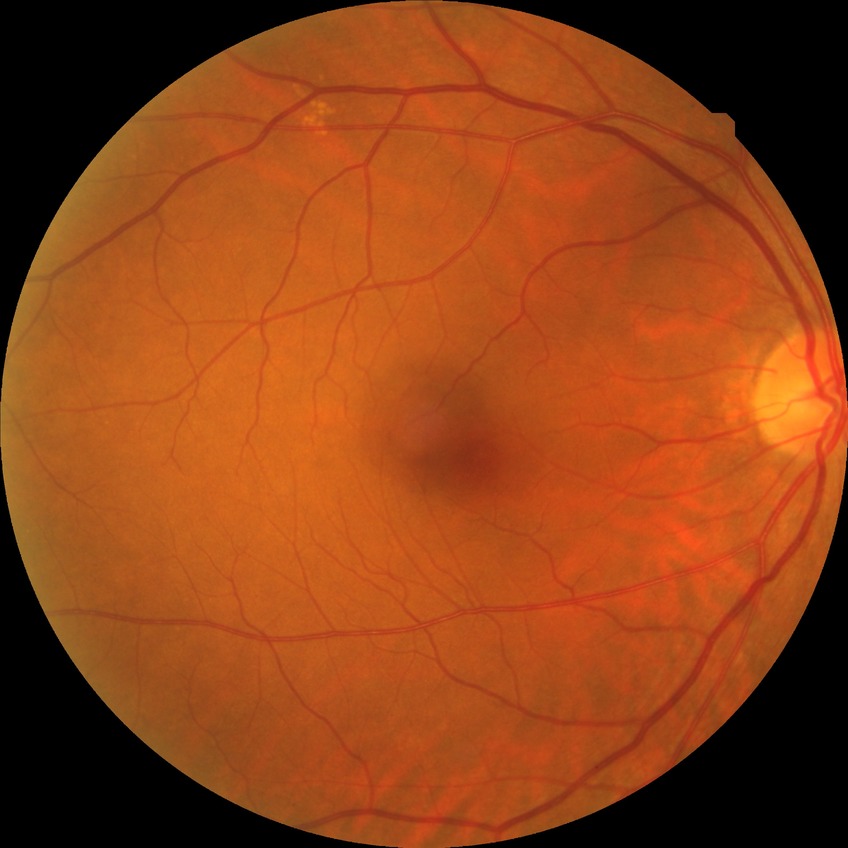

Diabetic retinopathy (DR): NDR (no diabetic retinopathy).